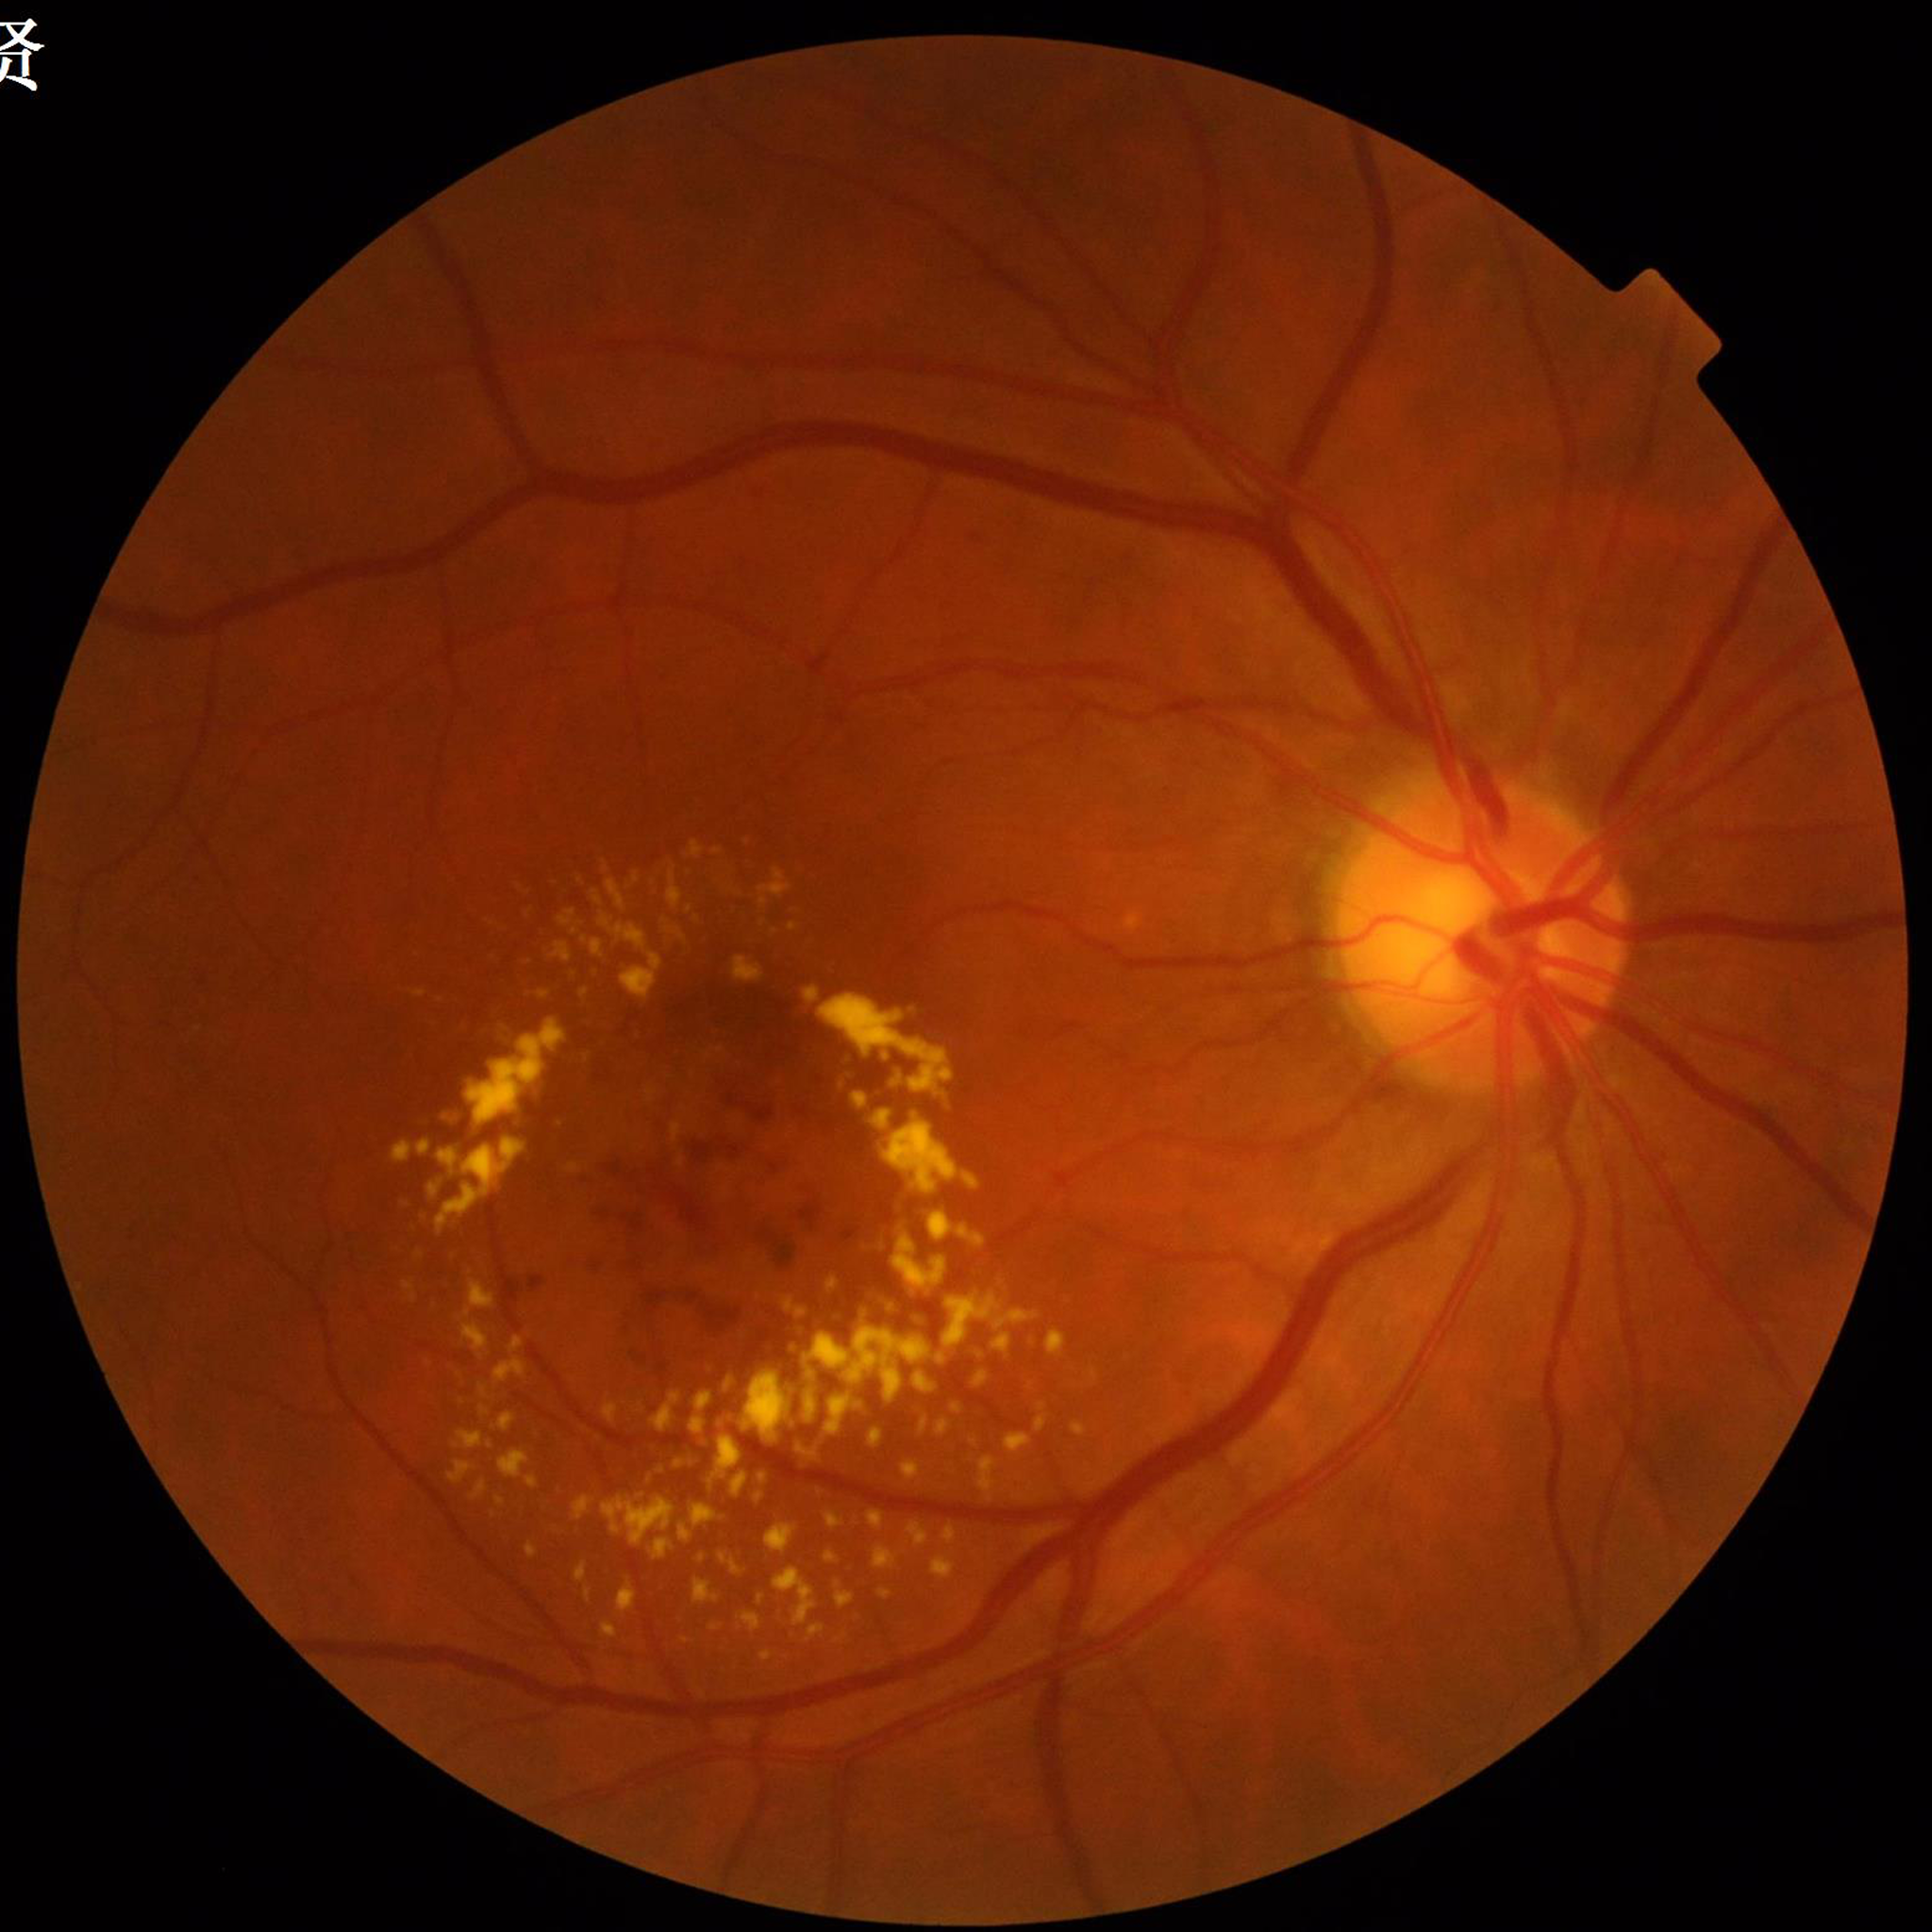 Retinal fundus photograph from a patient with diabetic retinopathy (DR). Image quality: no blur, illumination and color satisfactory, contrast adequate.